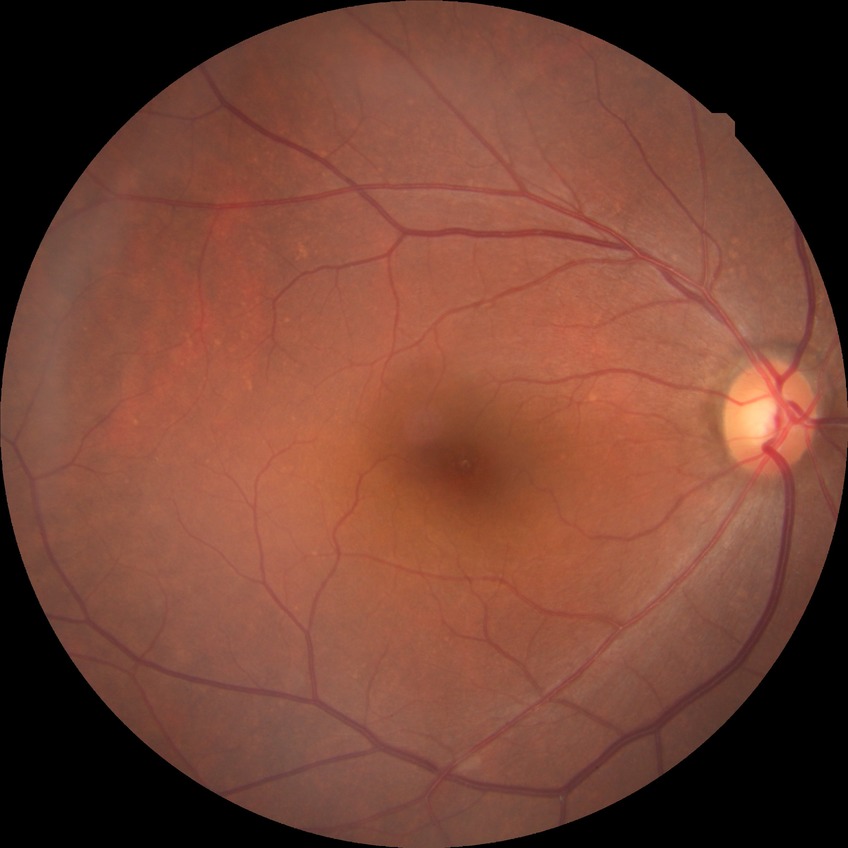 Diabetic retinopathy (DR): NDR (no diabetic retinopathy).